Wide-field fundus image from infant ROP screening.
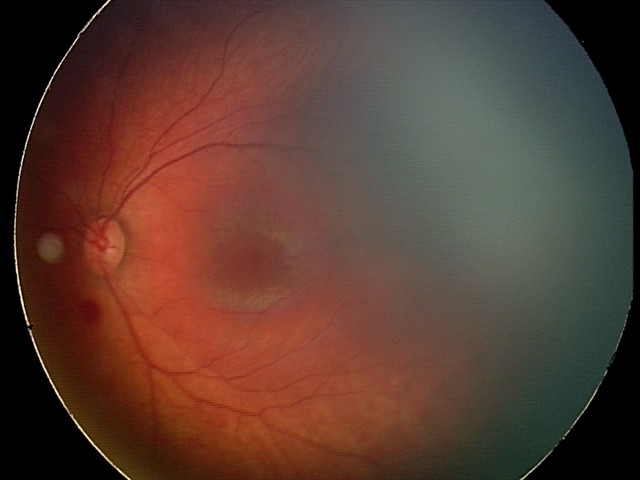

Diagnosis from this screening exam: retinal hemorrhages.